Acquired with a Nidek AFC-330: 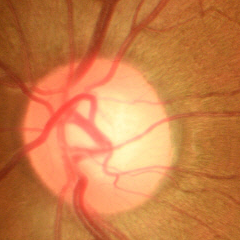
Fundus image with findings of no glaucomatous changes.